Posterior pole color fundus photograph · 848 x 848 pixels · 45° field of view · acquired with a NIDEK AFC-230: 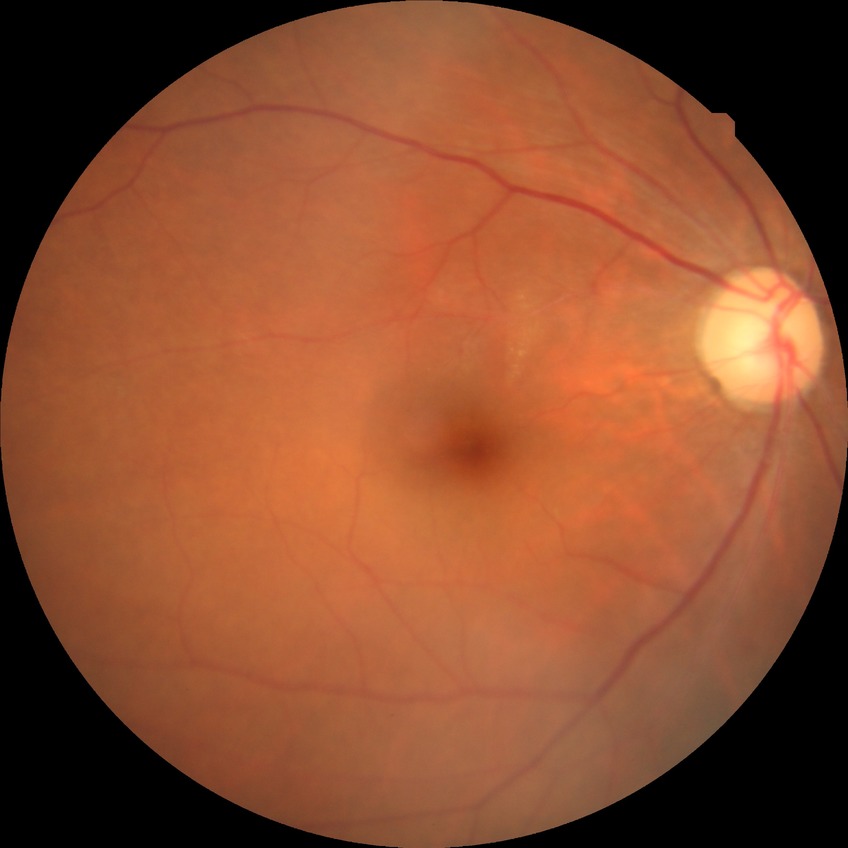

diabetic retinopathy (DR)=no diabetic retinopathy (NDR).